45-degree field of view. Retinal fundus photograph — 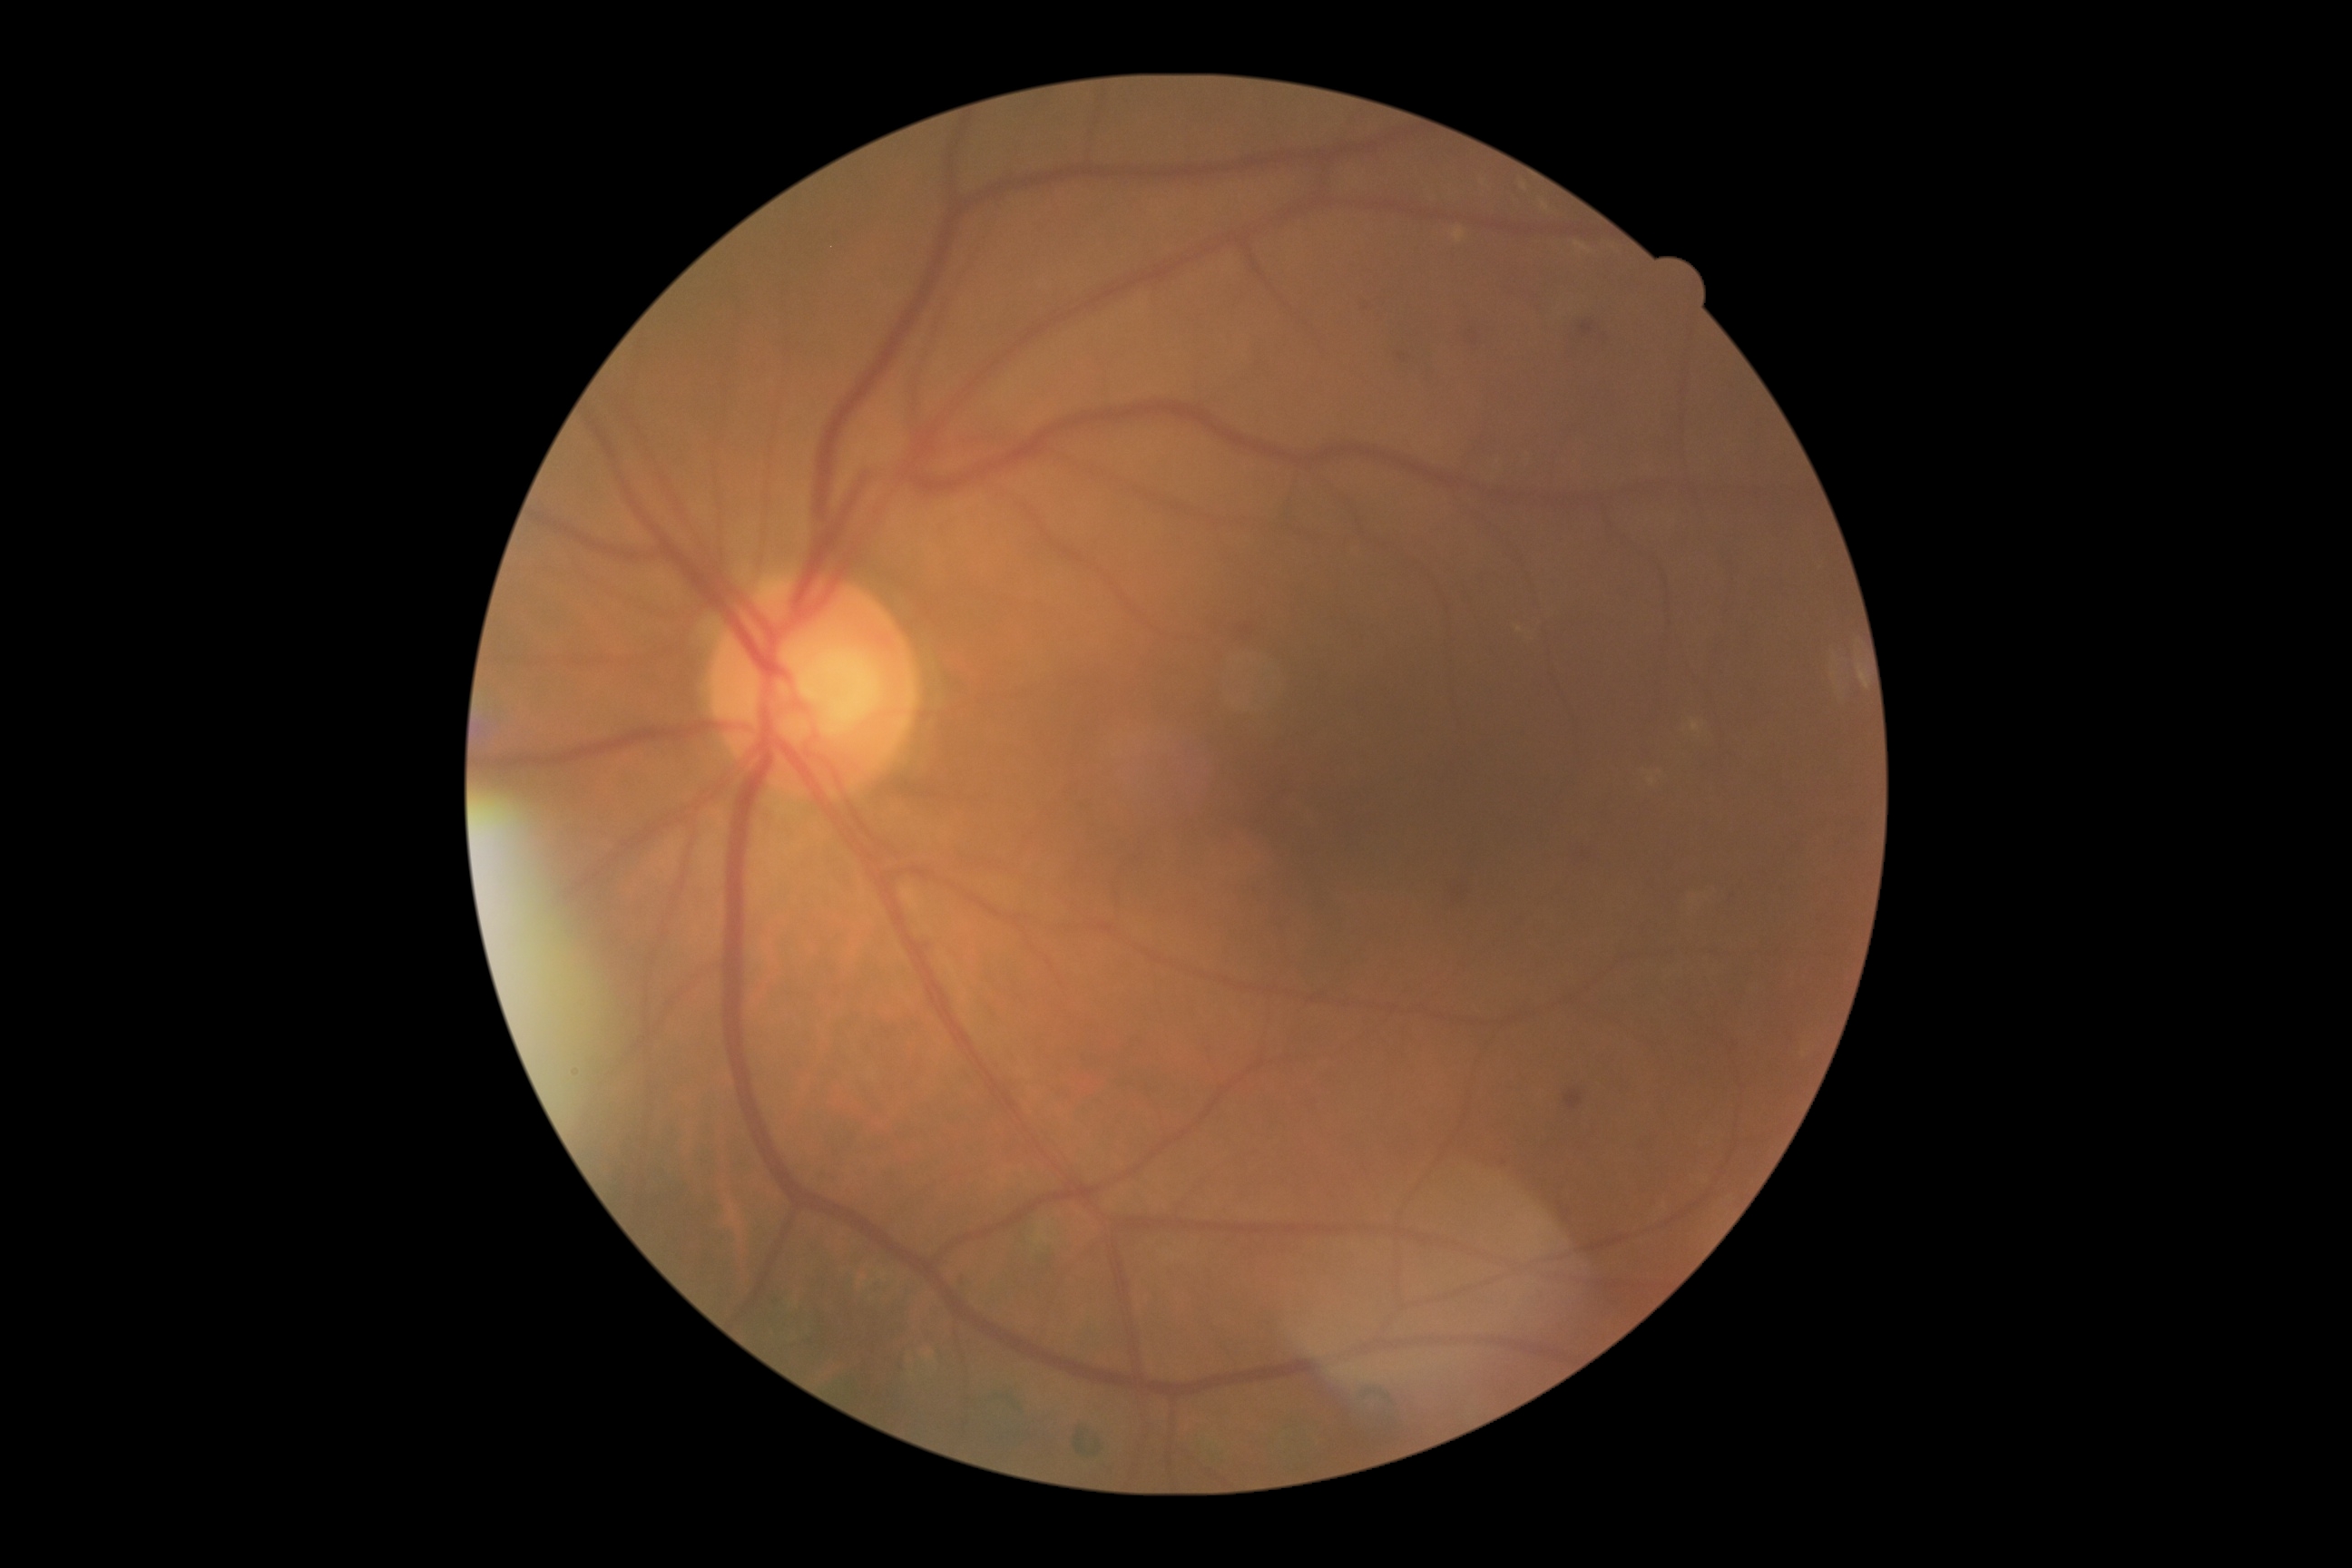 Disease class: non-proliferative diabetic retinopathy. Diabetic retinopathy is moderate NPDR (grade 2).